848x848px. 45 degree fundus photograph. CFP. Nonmydriatic fundus photograph. Camera: NIDEK AFC-230
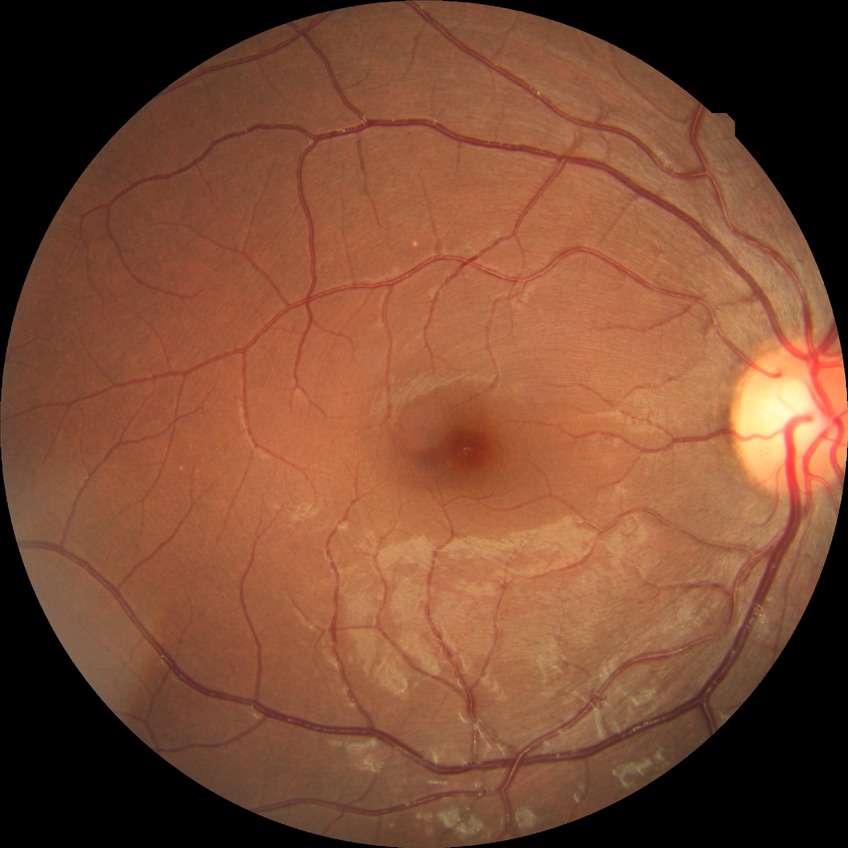
diabetic retinopathy grade = no diabetic retinopathy